RetCam wide-field infant fundus image: 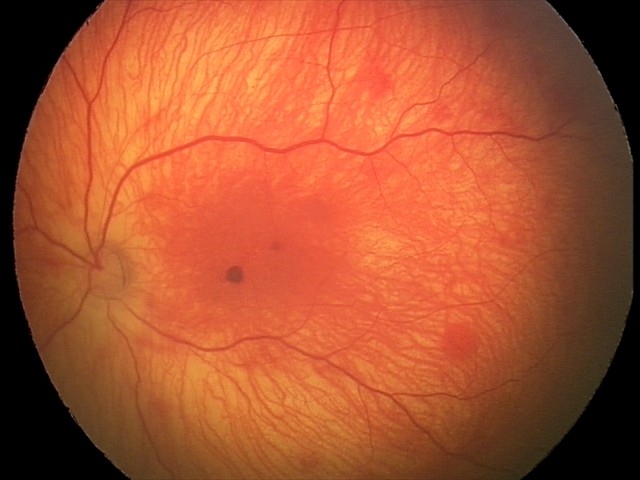

Examination diagnosed as retinal hemorrhages.